240 by 240 pixels.
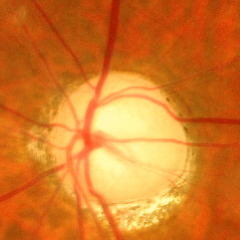
Showing advanced-stage glaucoma.